Infant wide-field fundus photograph
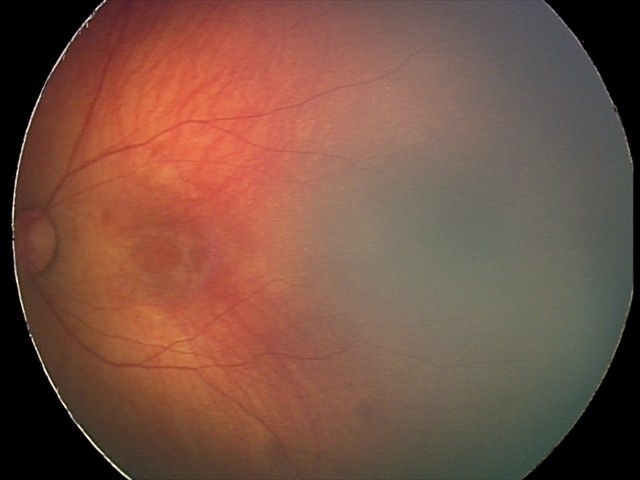
Screening diagnosis: retinal hemorrhages.